Nonmydriatic; 848x848px; posterior pole photograph; camera: NIDEK AFC-230; FOV: 45 degrees
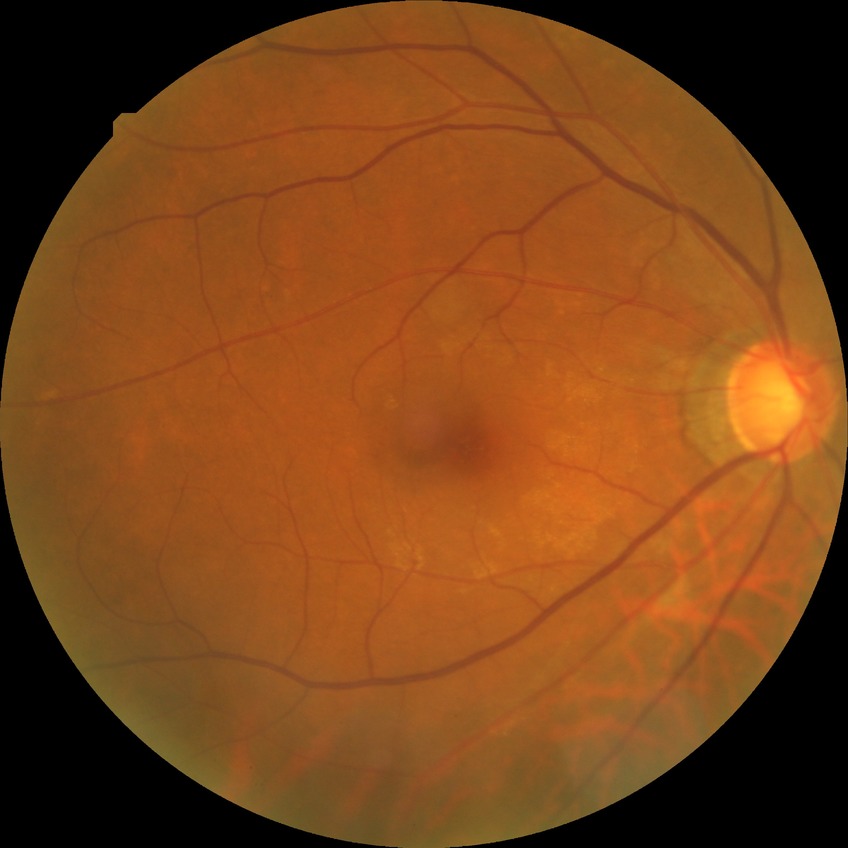

{
  "davis_grade": "NDR"
}